Modified Davis grading — 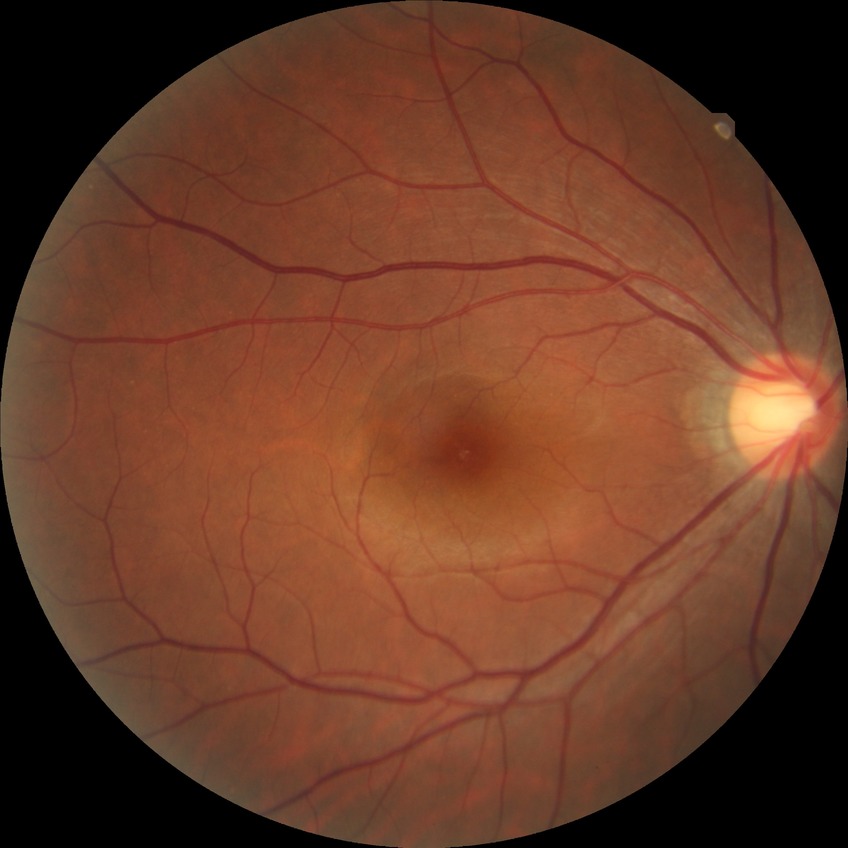

retinopathy grade@no diabetic retinopathy.